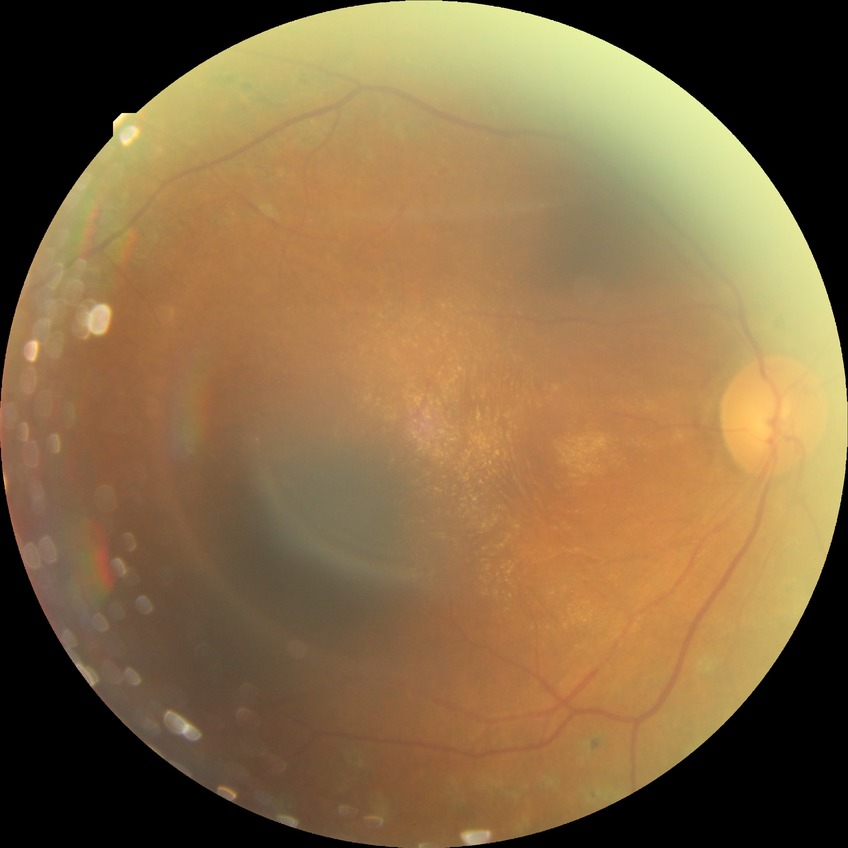

{"davis_grade": "proliferative diabetic retinopathy"}